NIDEK AFC-230 fundus camera, 848x848, graded on the modified Davis scale
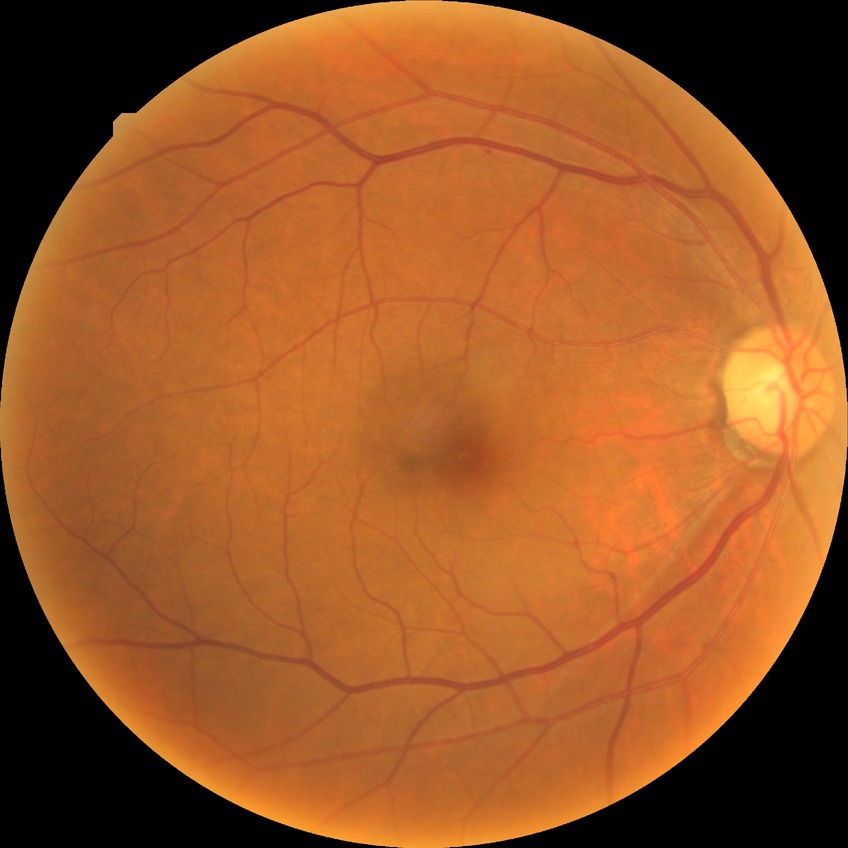
Diabetic retinopathy (DR): SDR (simple diabetic retinopathy).